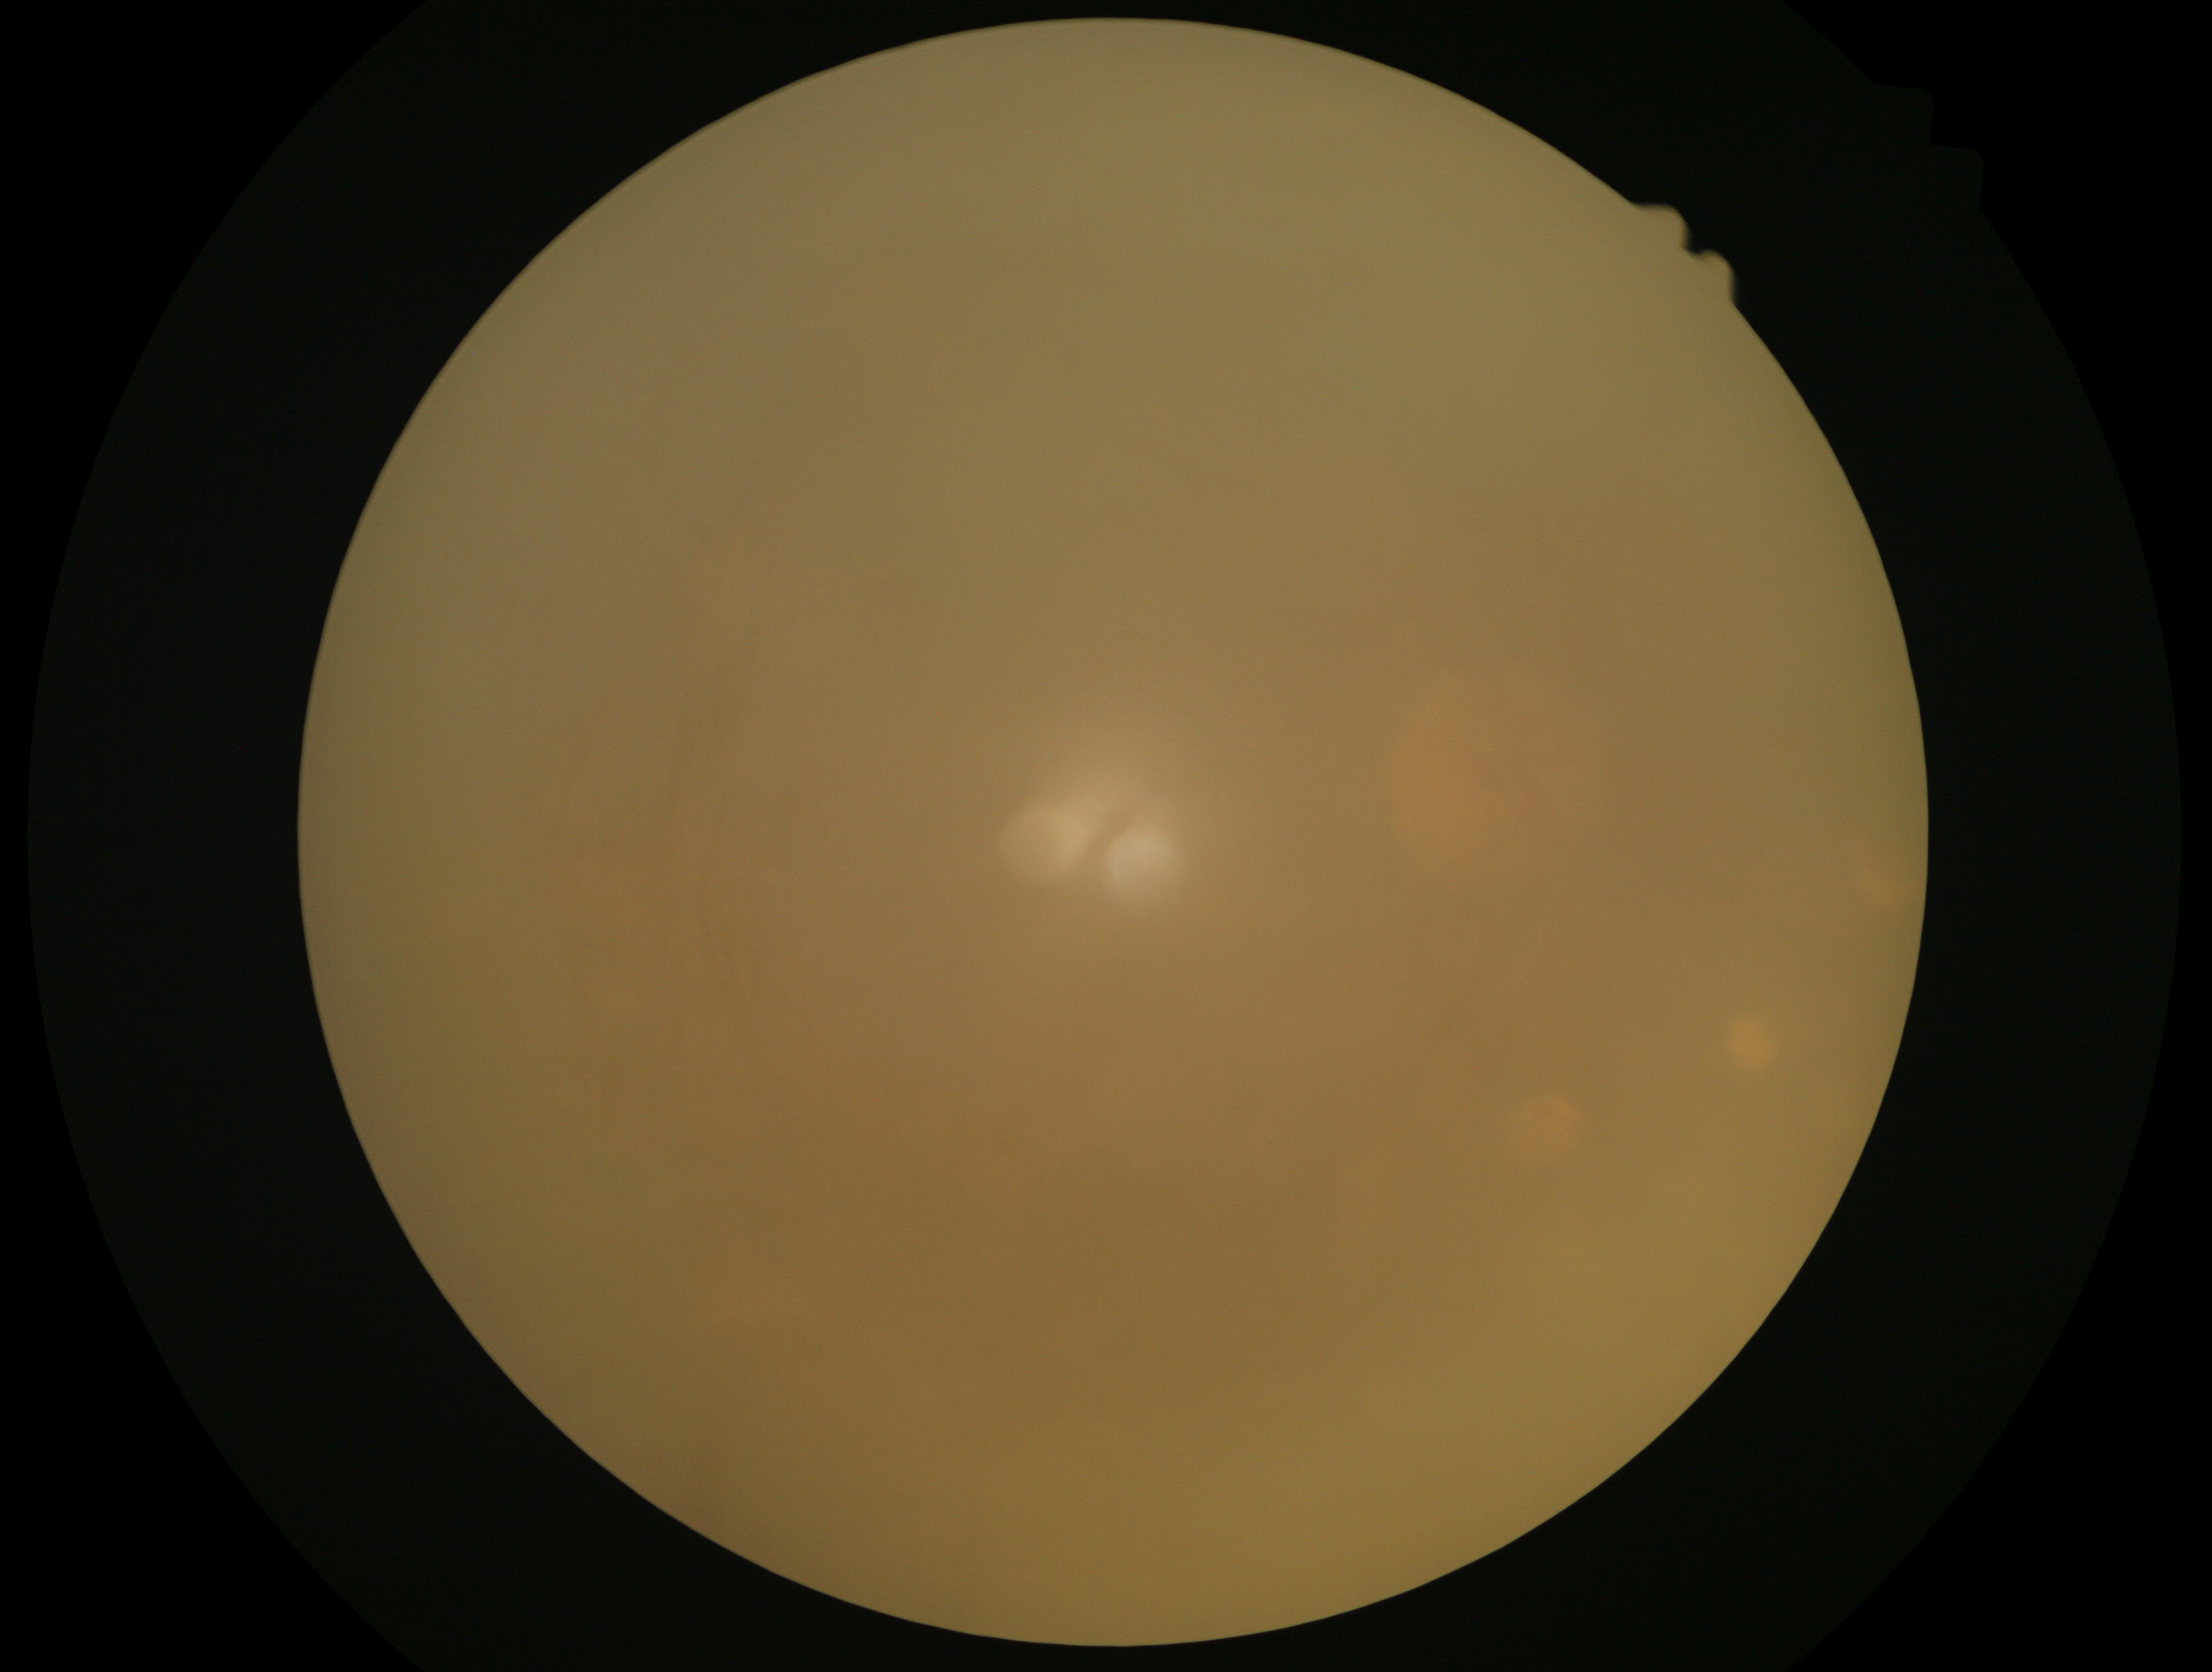 Findings:
• diabetic retinopathy: ungradable